1932x1932px · color fundus photograph · centered on the macula
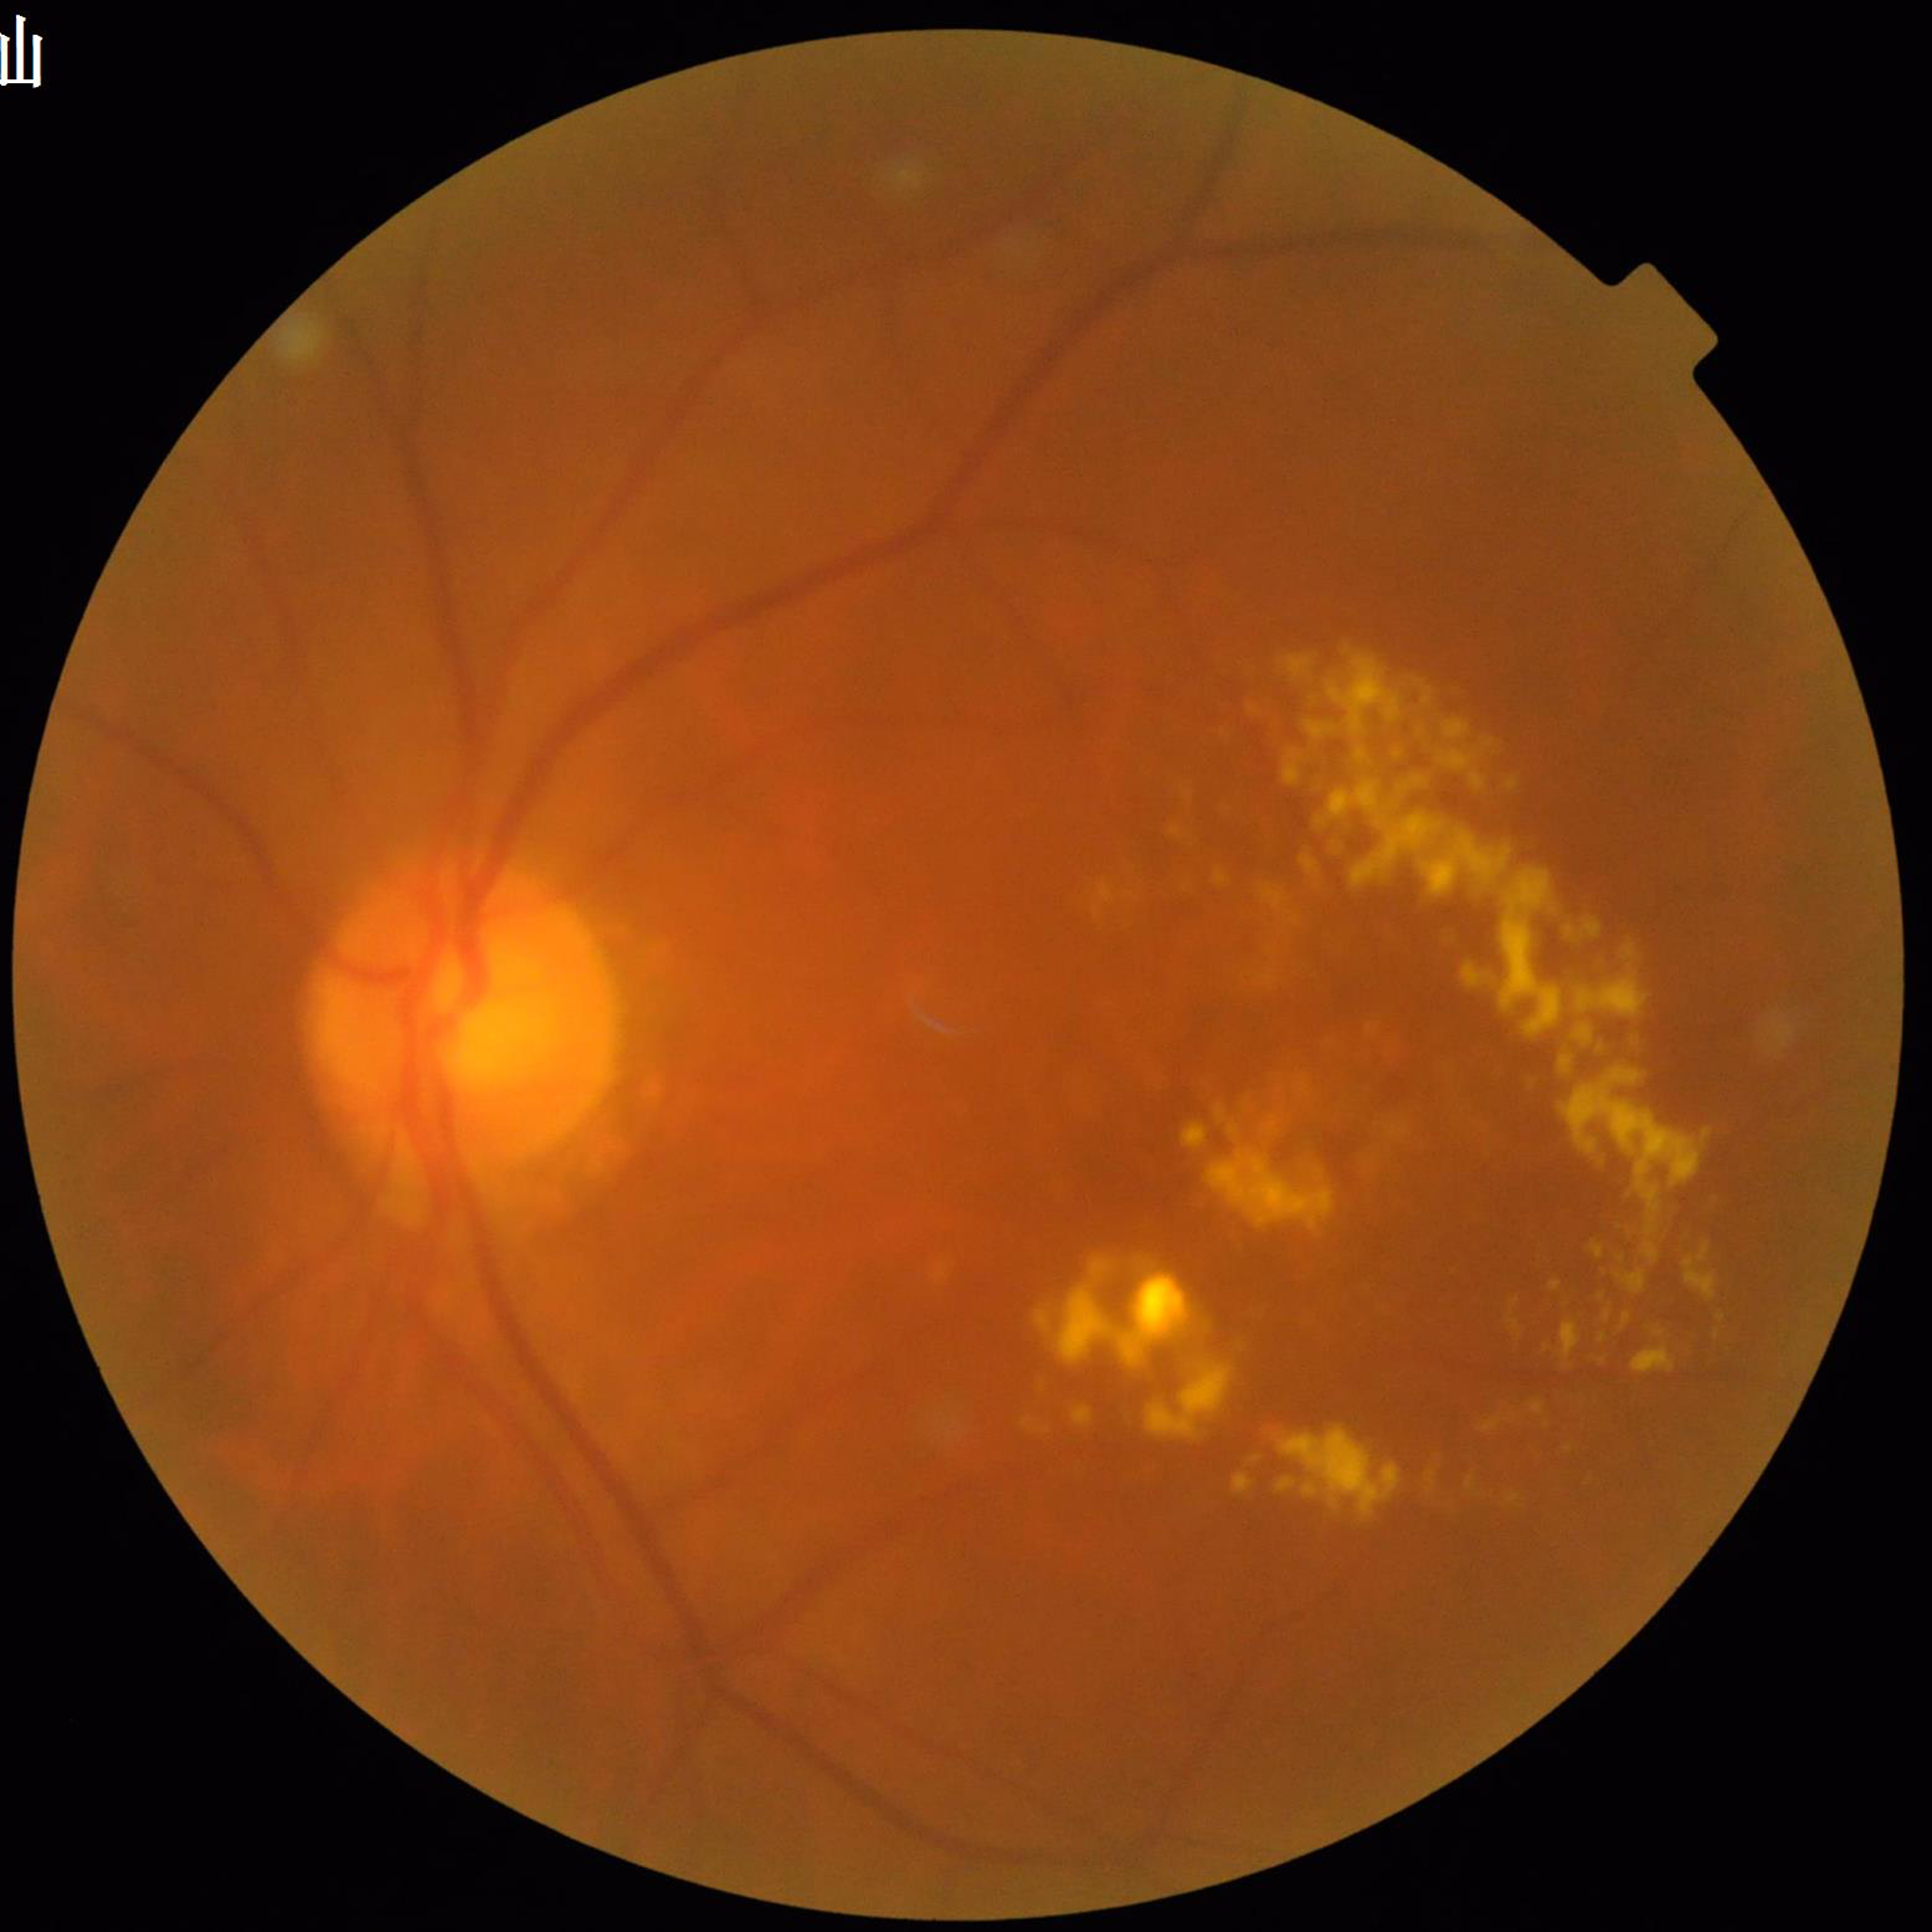 From a patient with age-related macular degeneration.
Quality: blur present, contrast adequate, illumination and color satisfactory.